DR severity per modified Davis staging:
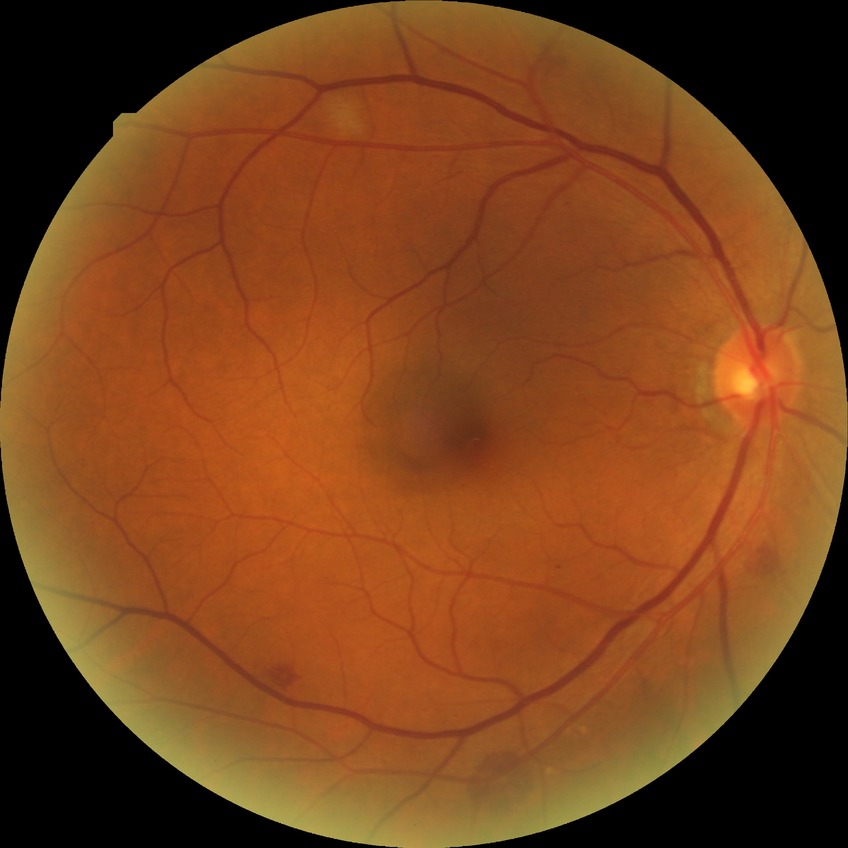 diabetic retinopathy (DR): NDR (no diabetic retinopathy).